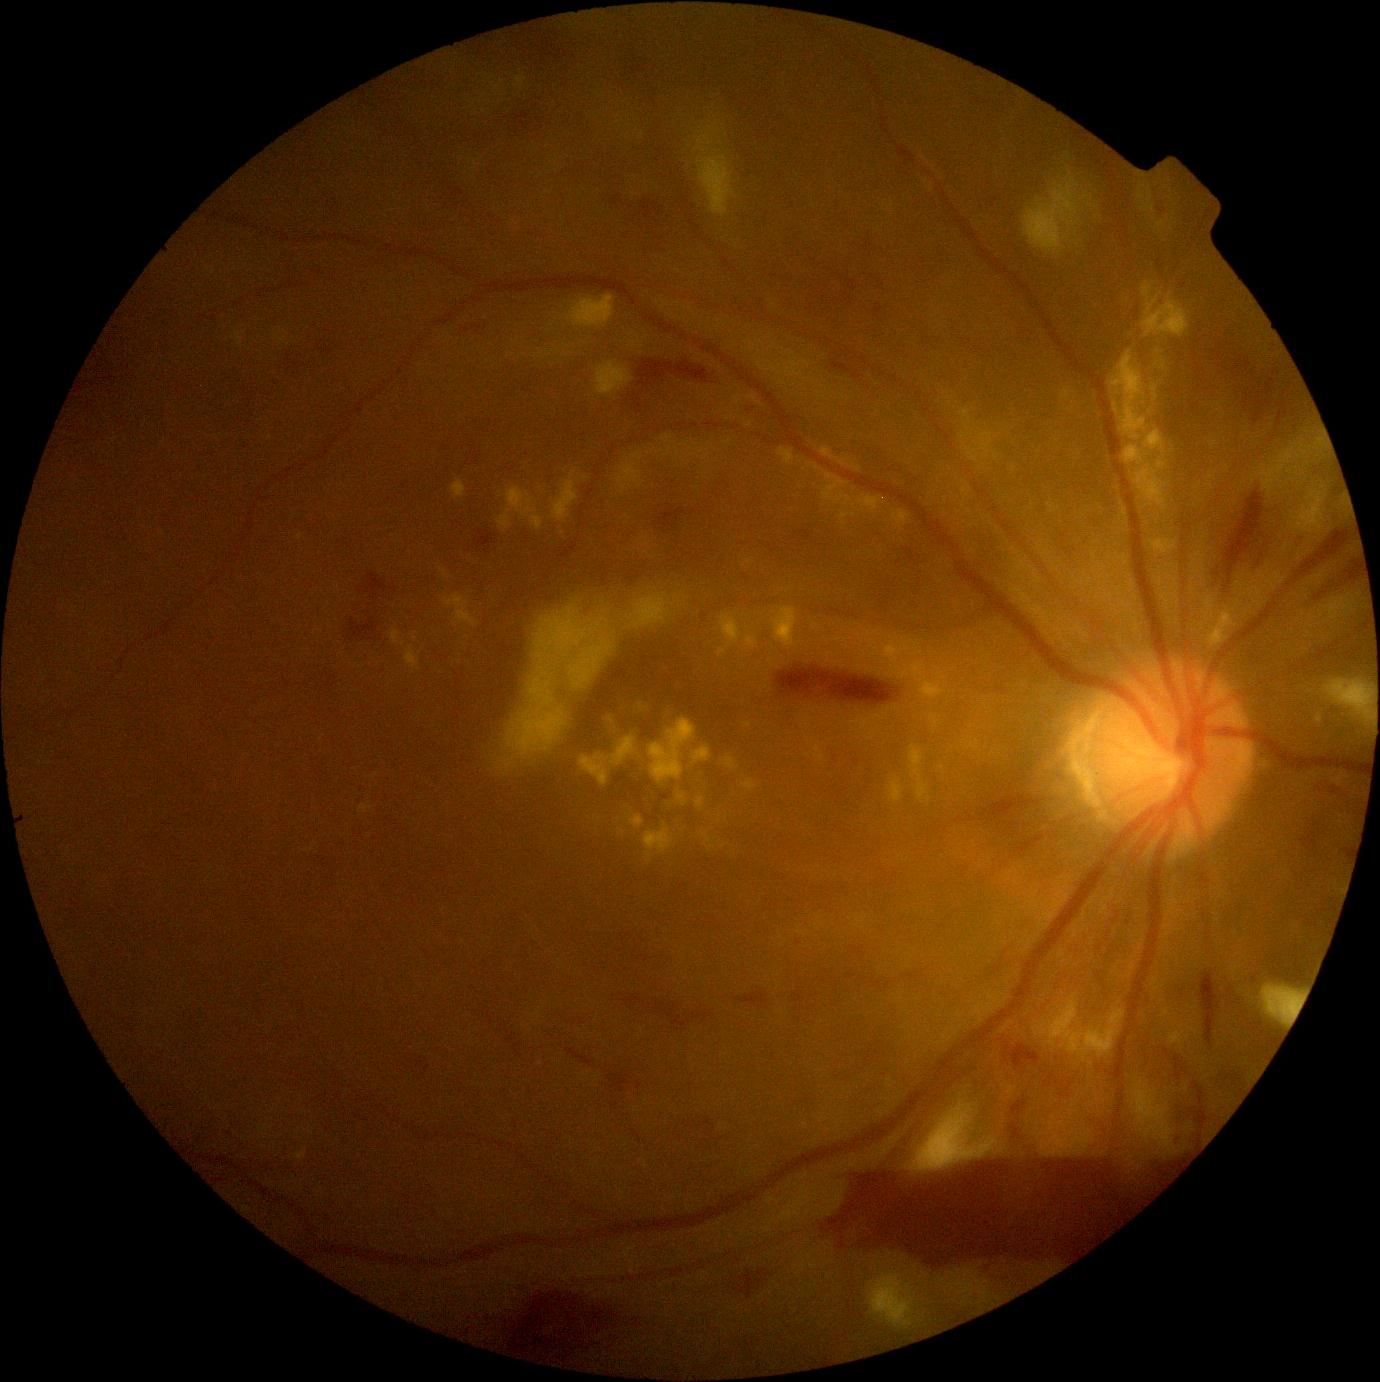

Diabetic retinopathy (DR): 4/4
Representative lesions:
hard exudates (EXs) (more not shown): 742/779/756/792; 718/615/742/657; 900/664/927/678; 909/744/930/800; 815/465/853/507; 440/568/447/577; 822/448/835/460; 682/441/690/447; 859/495/884/513; 451/479/466/500; 702/449/711/461; 696/798/704/810; 1112/351/1147/441
Small EXs approximately at 816/627; 416/640; 677/449; 692/449; 942/768